NIDEK AFC-230:
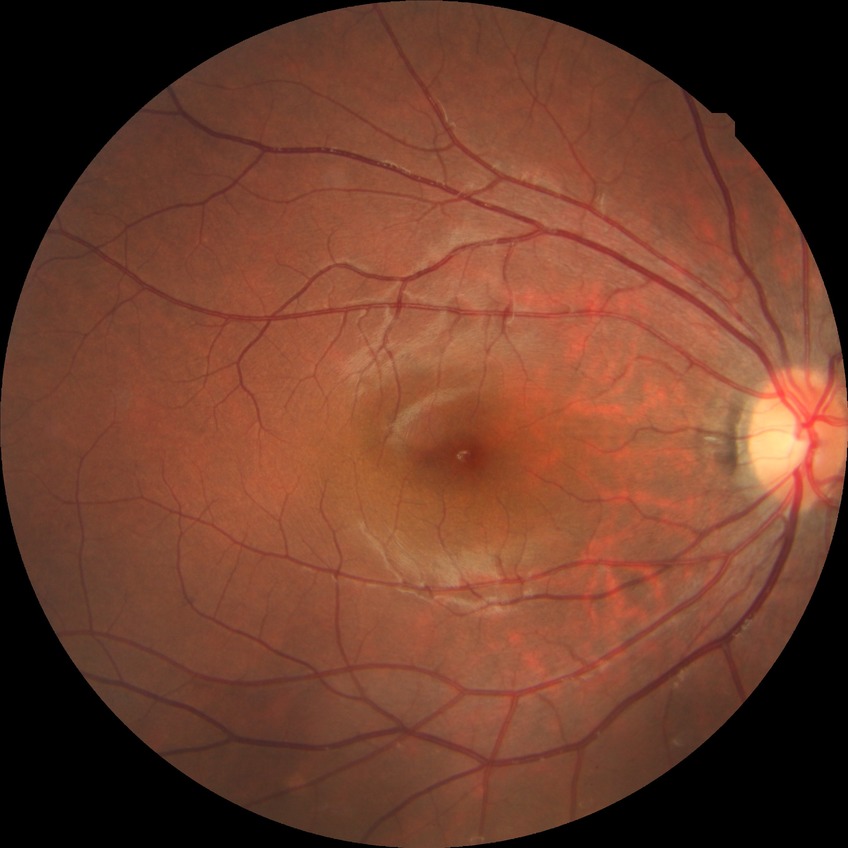

Davis DR grade: NDR.